848x848 · diabetic retinopathy graded by the modified Davis classification: 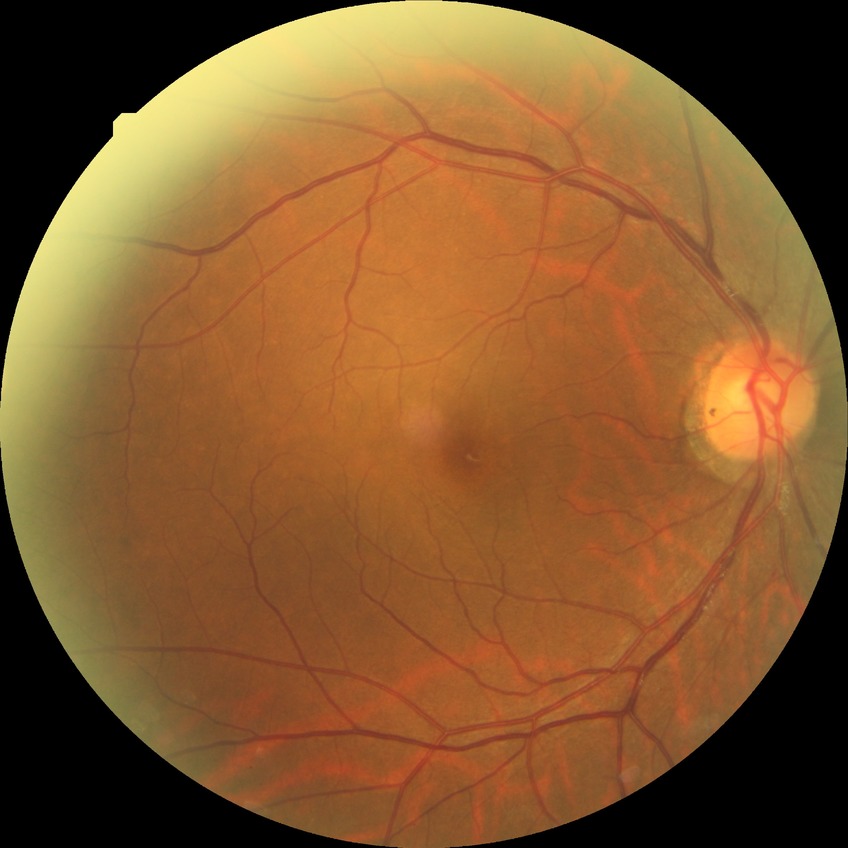
Diabetic retinopathy (DR) is no diabetic retinopathy (NDR).